Nonmydriatic fundus photograph. Diabetic retinopathy graded by the modified Davis classification: 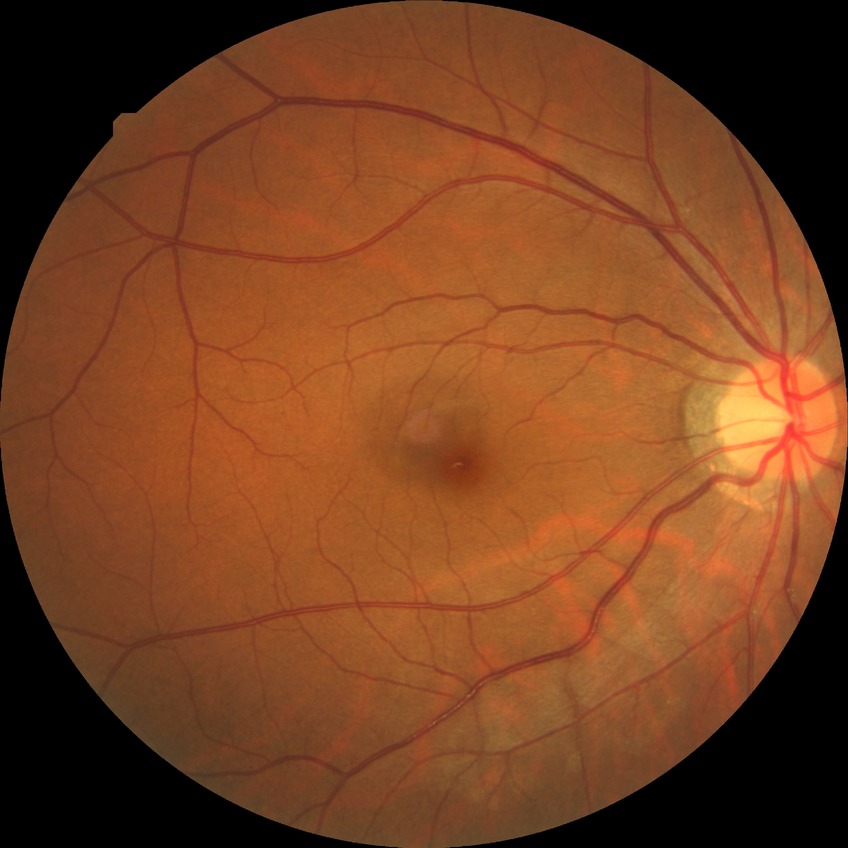
diabetic retinopathy (DR)@NDR (no diabetic retinopathy).